Infant wide-field fundus photograph. Image size 640x480. Camera: Clarity RetCam 3 (130° FOV).
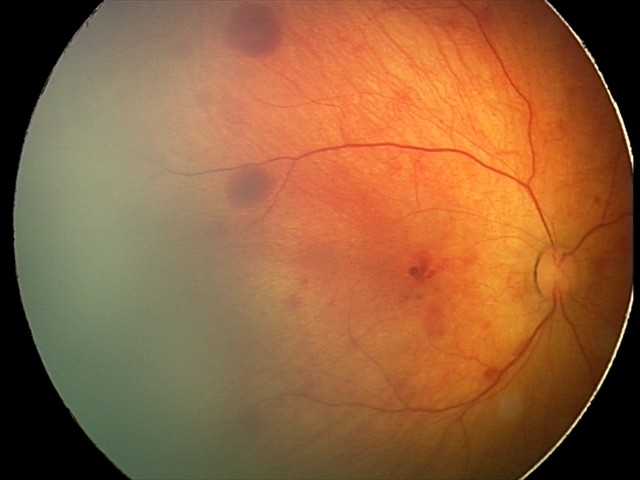
Impression: retinal hemorrhages.